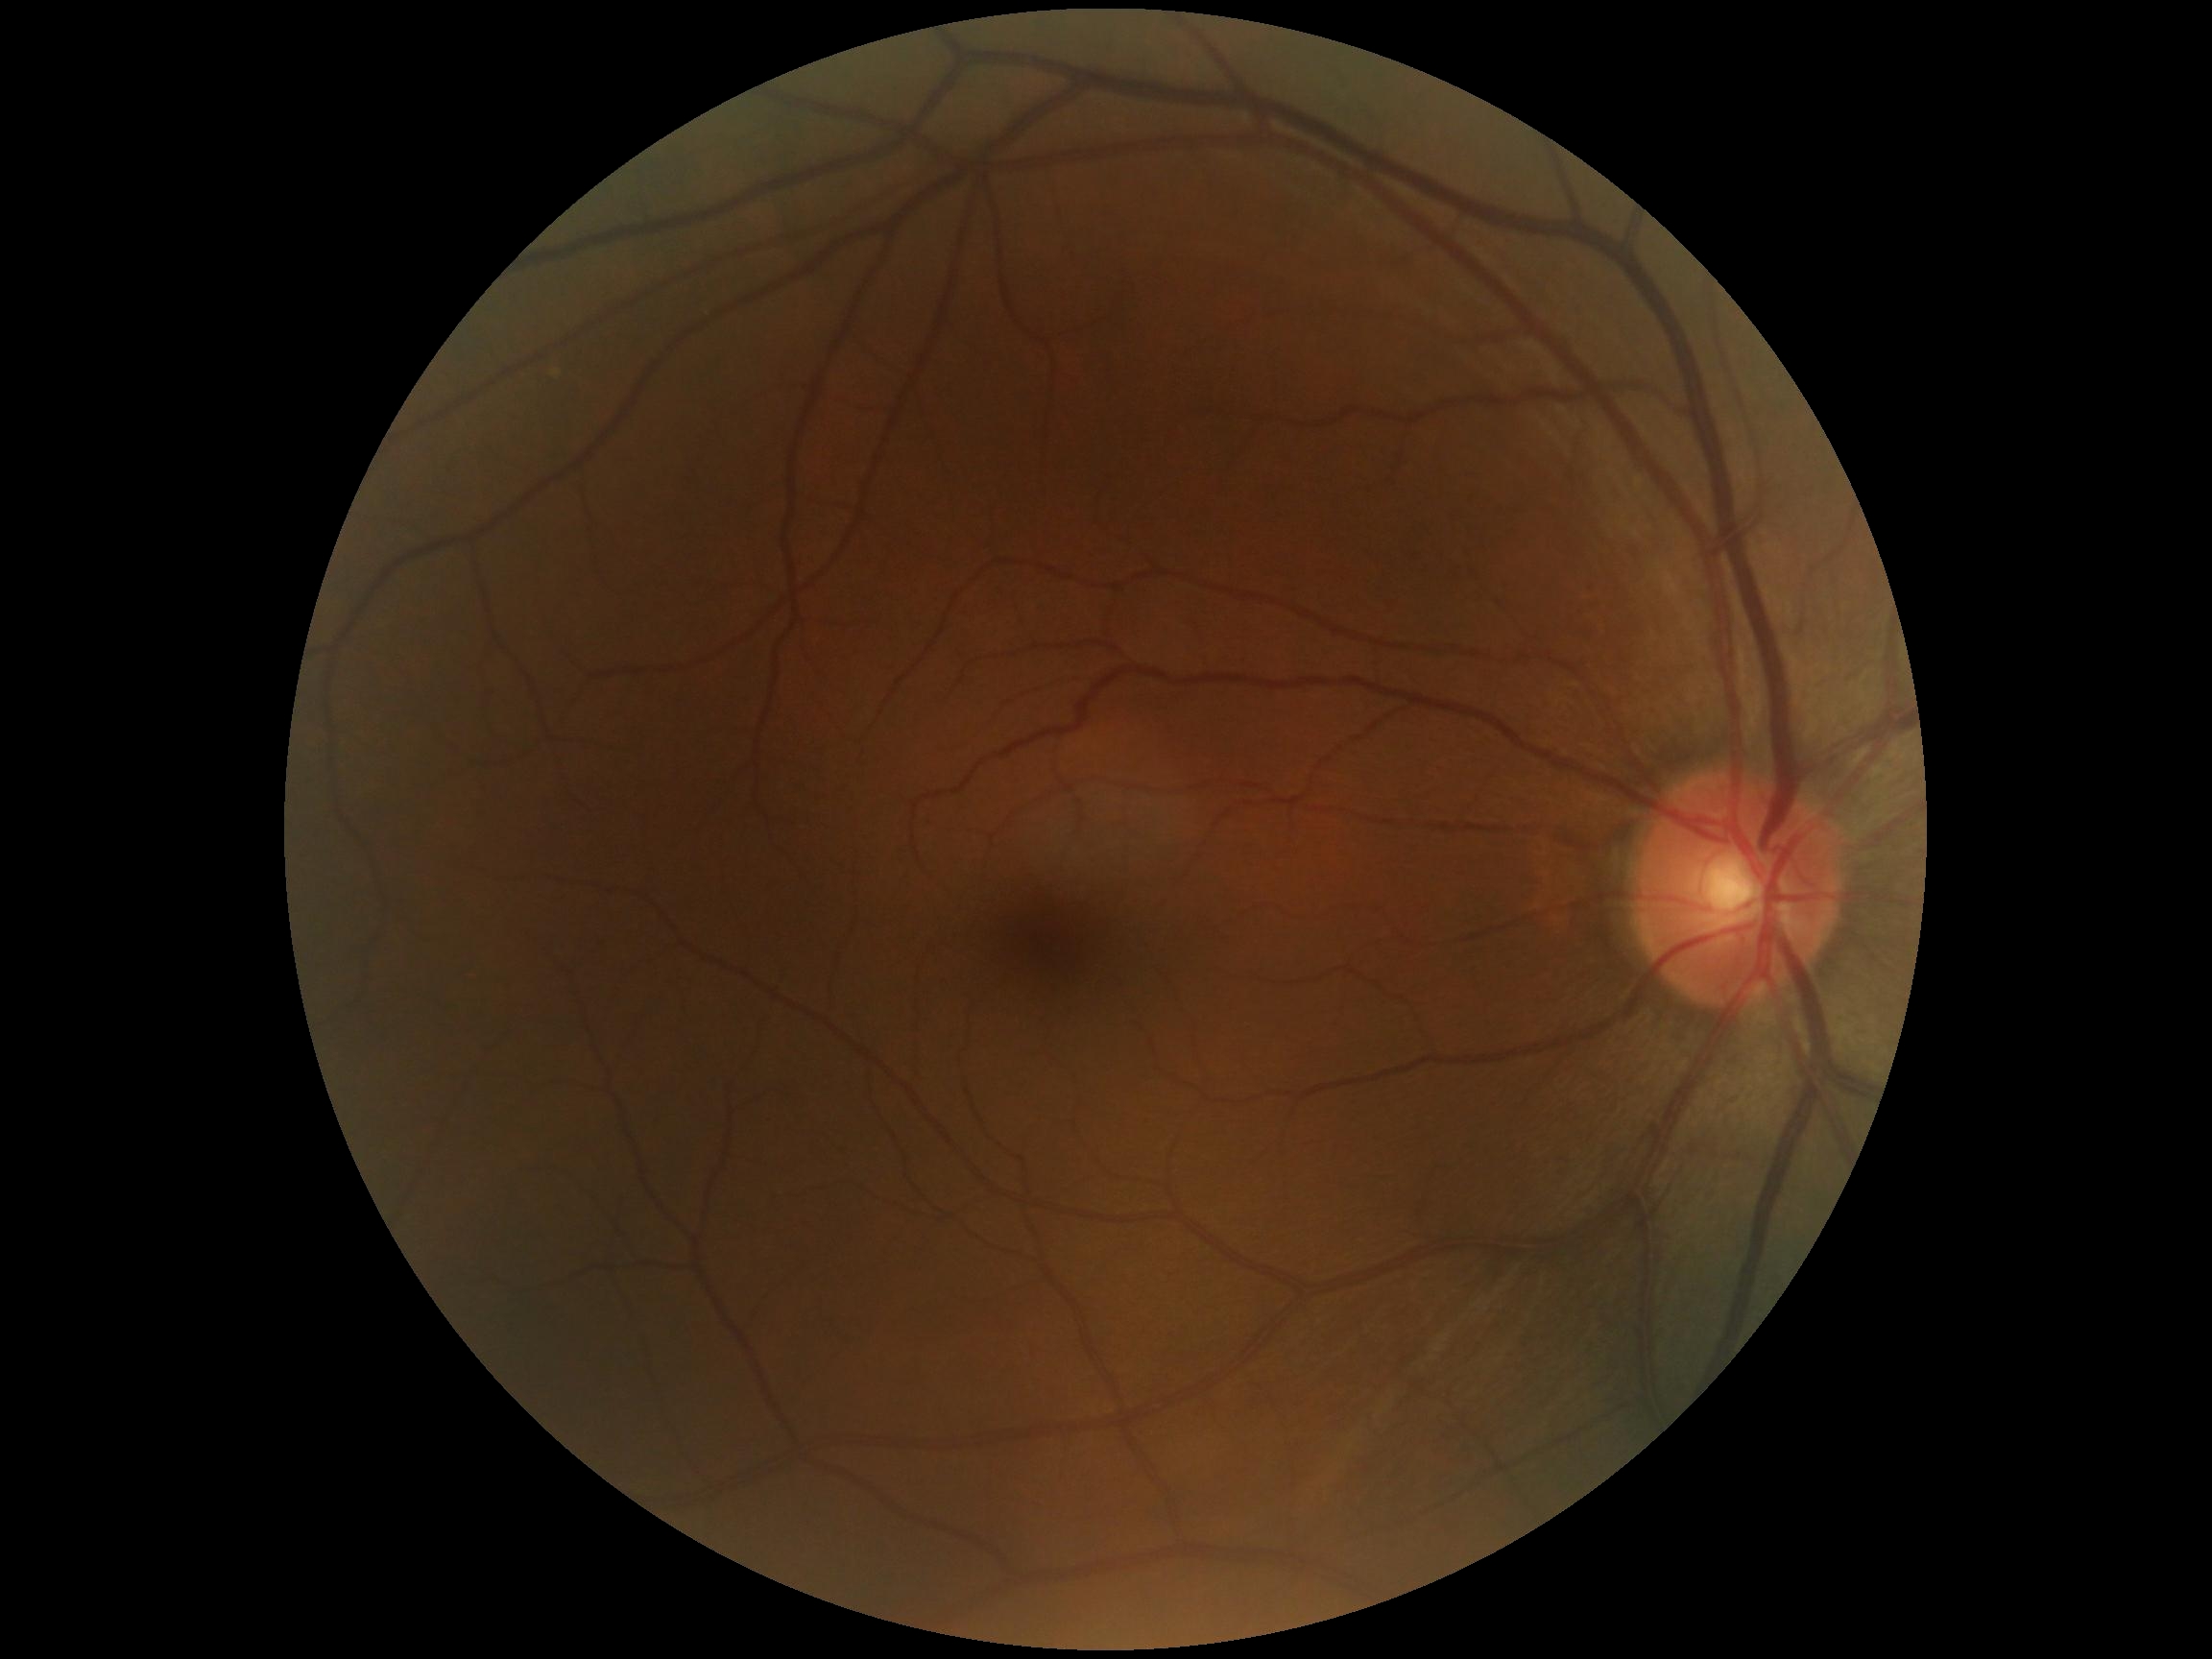
DR severity: grade 0.